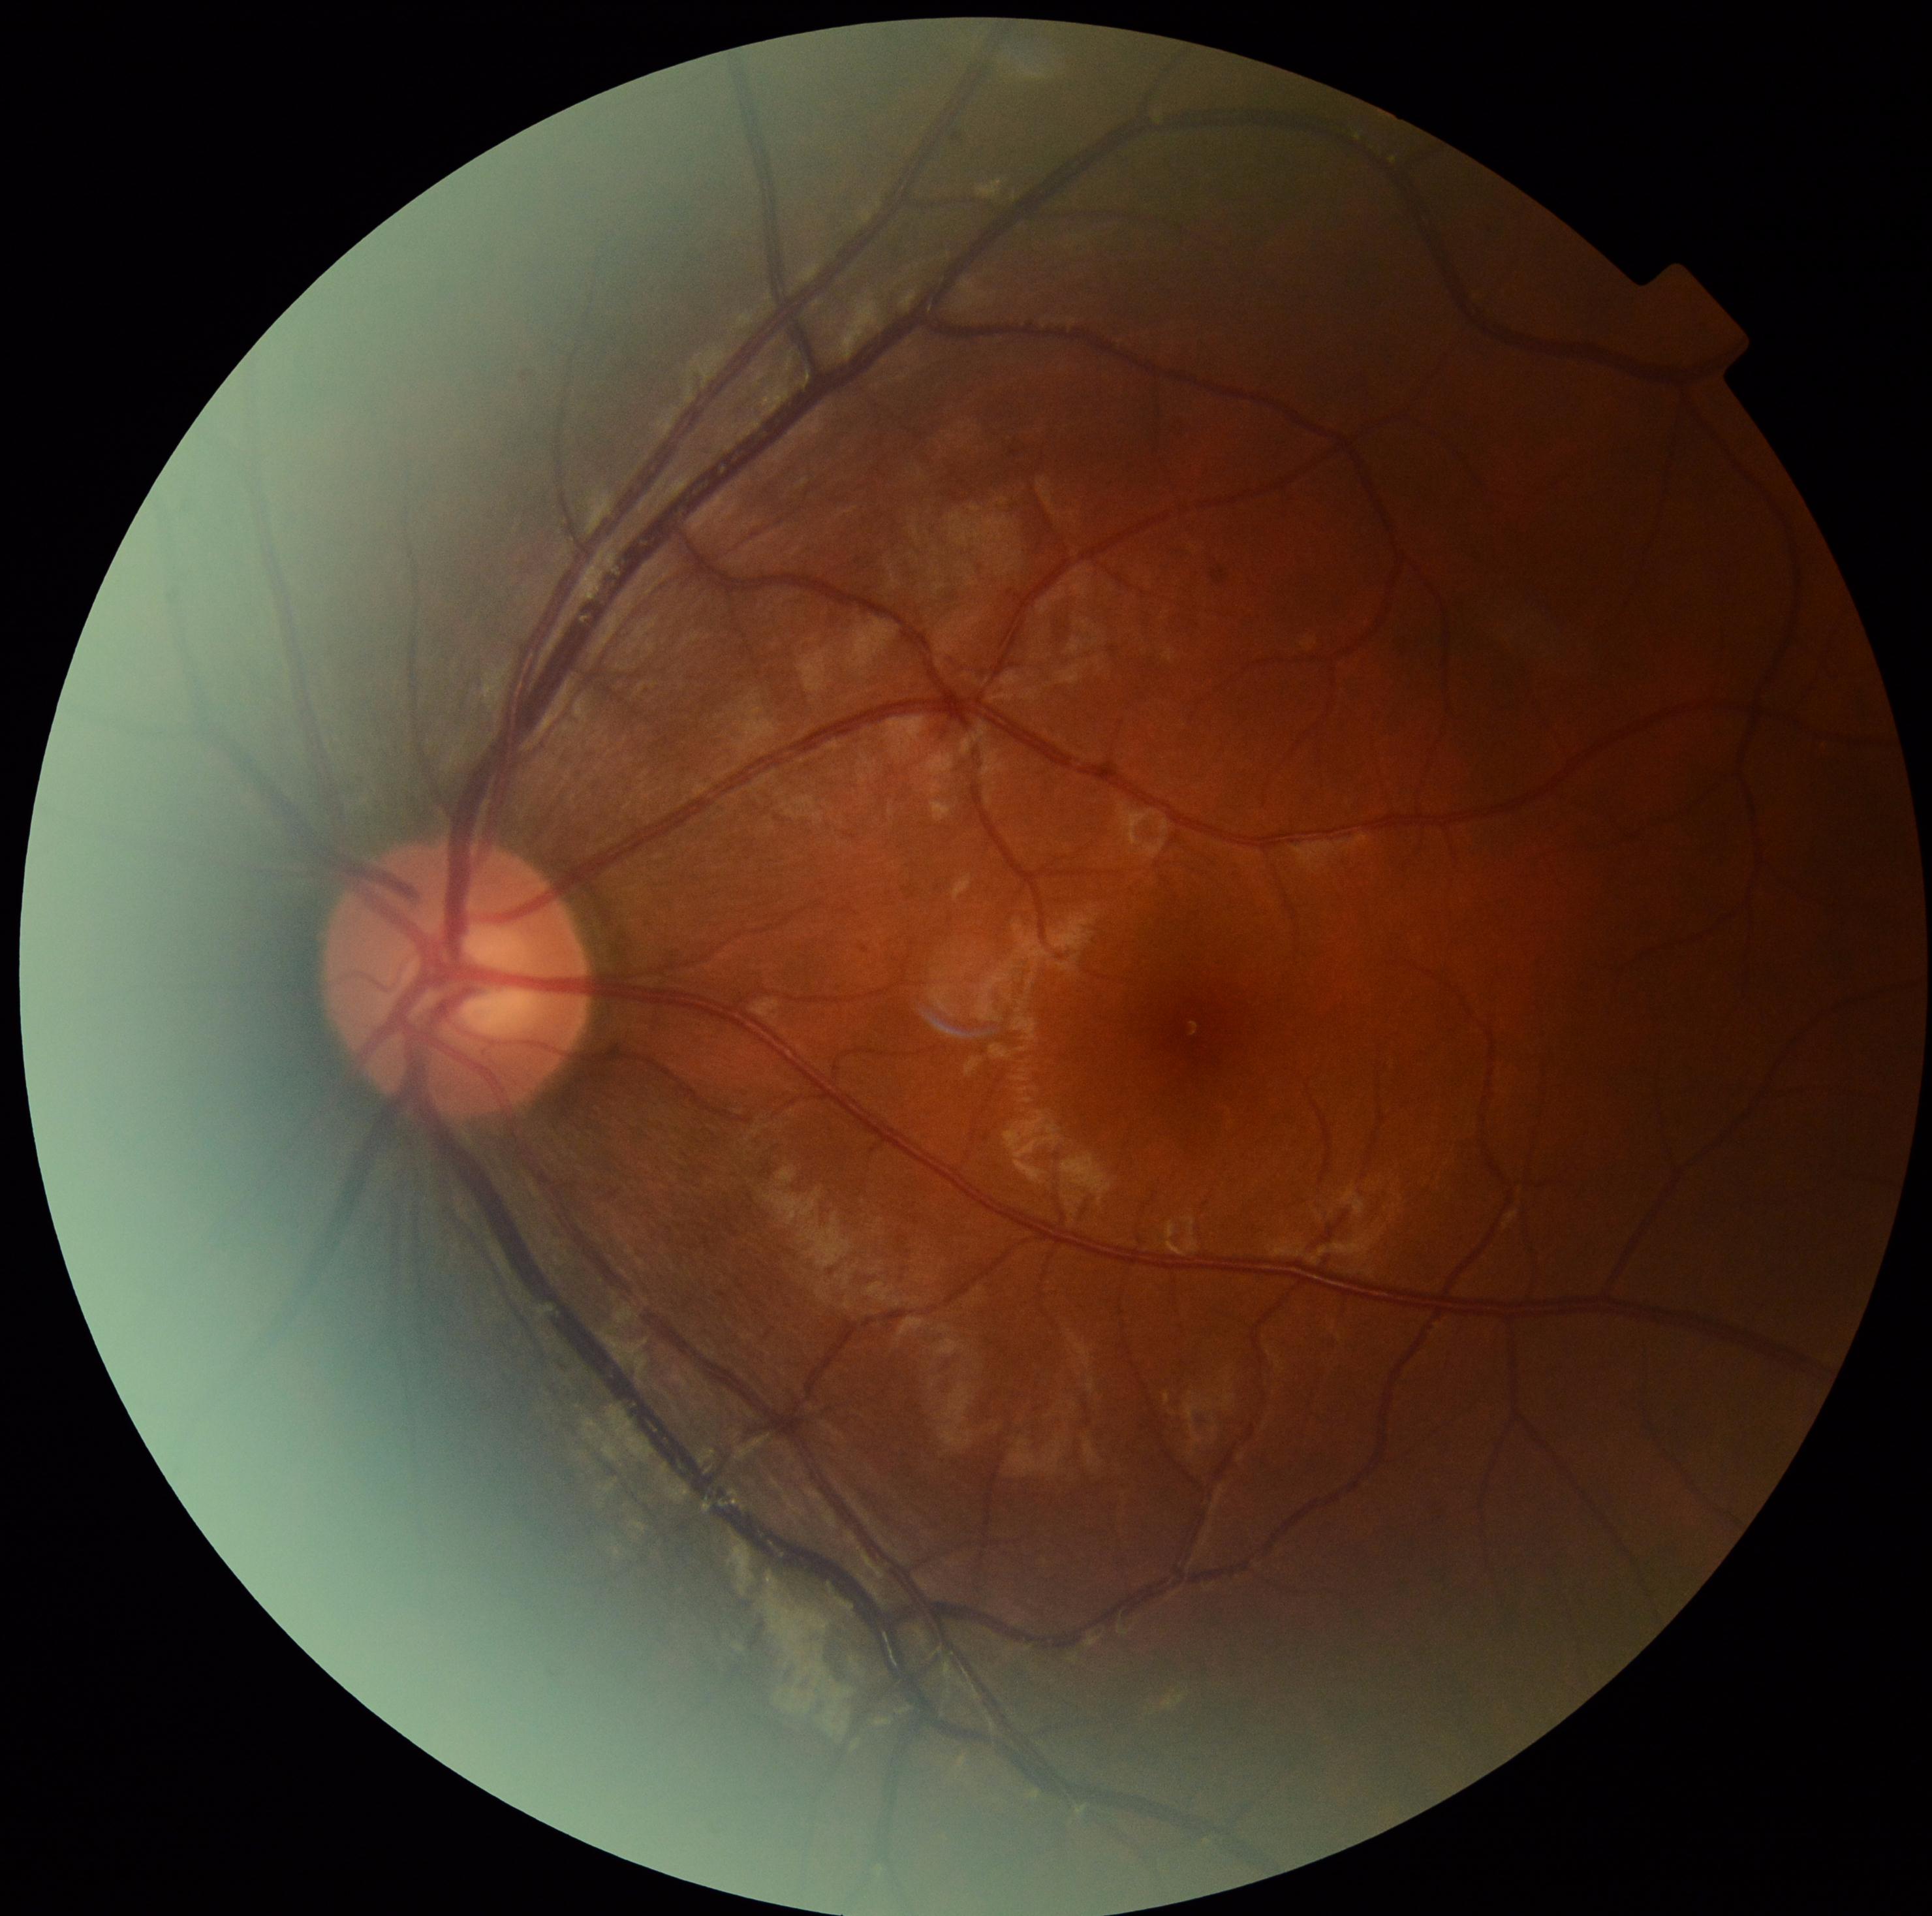 Retinopathy is 0 — no visible signs of diabetic retinopathy.